1440x1080px · wide-field fundus photograph of an infant
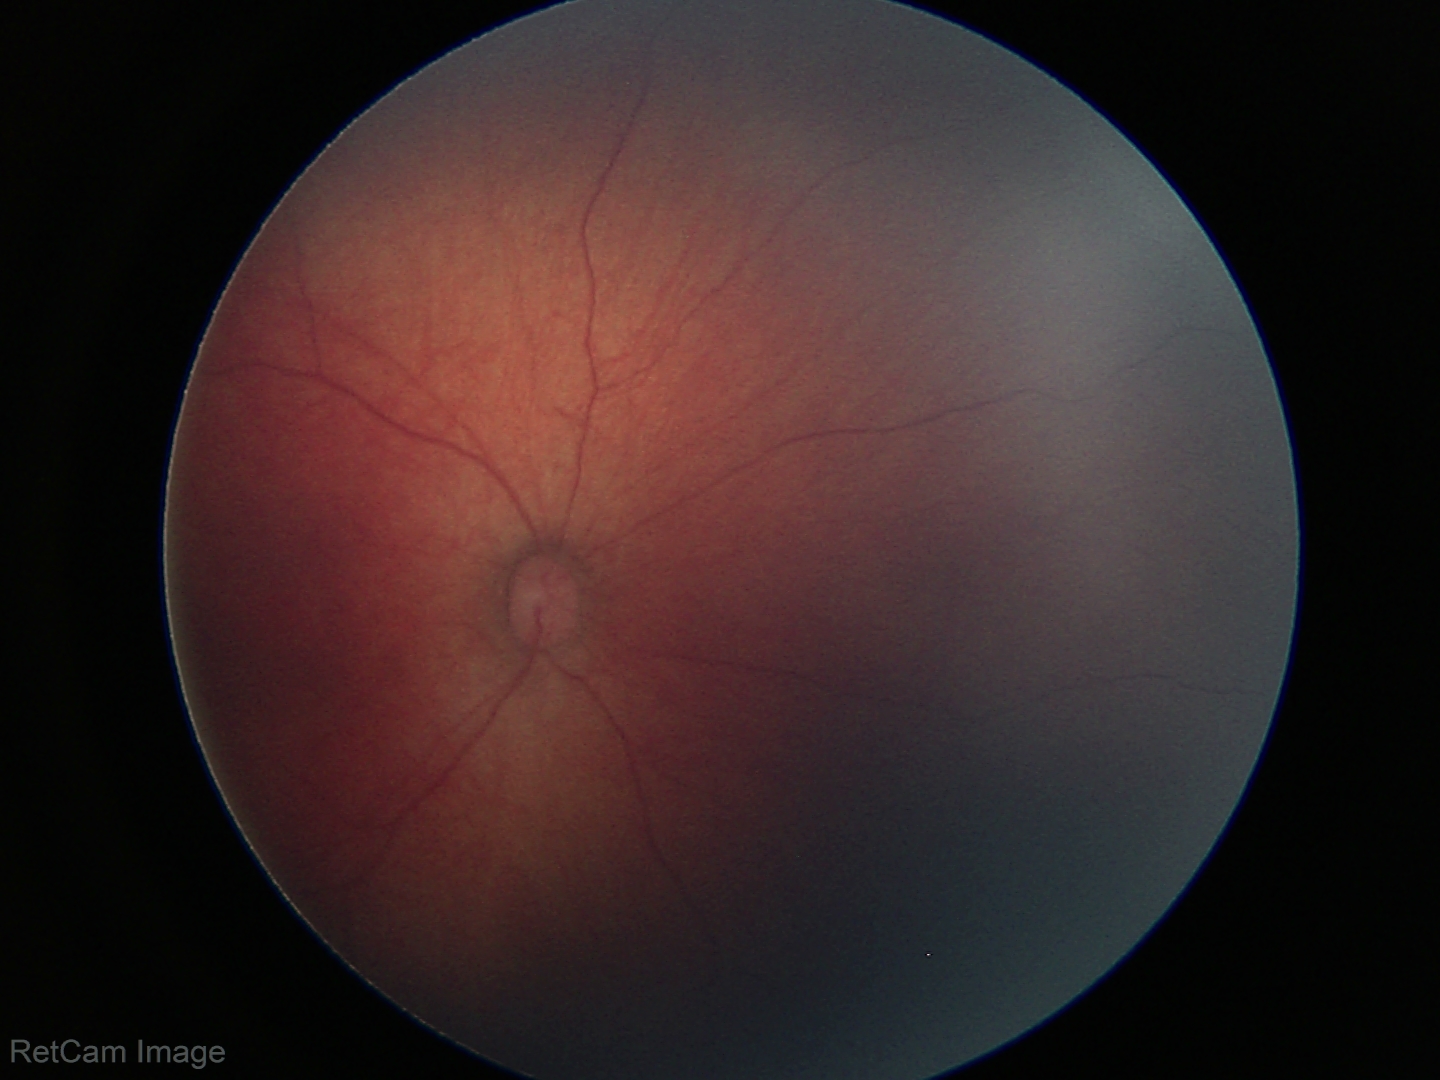

Screening diagnosis: physiological appearance.